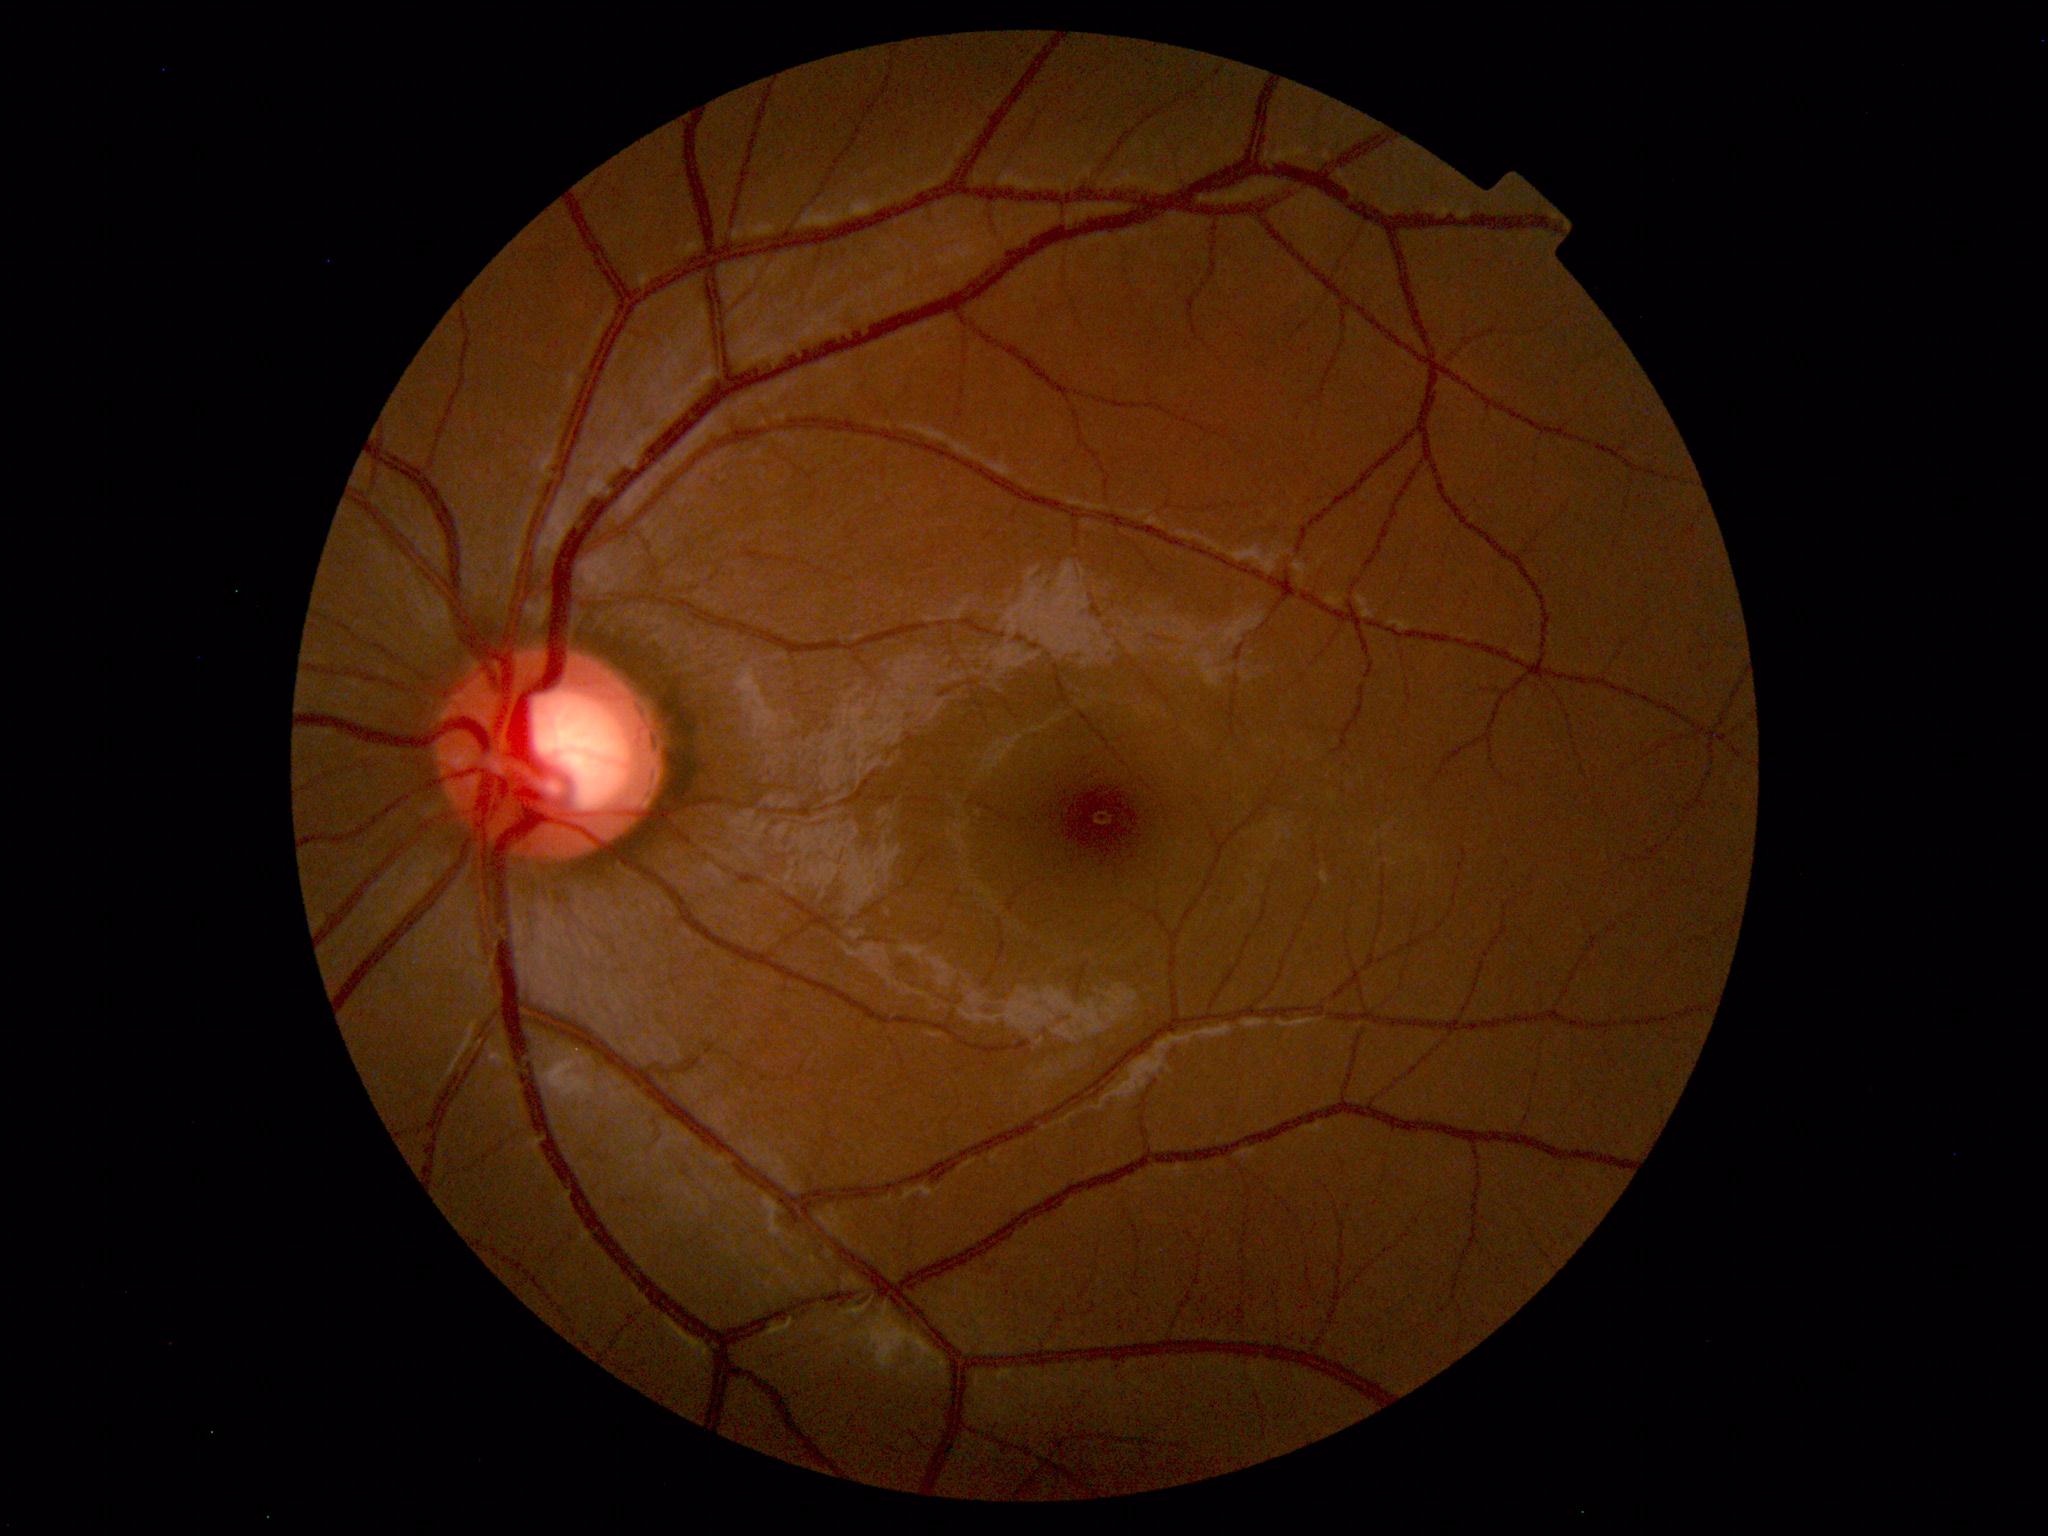

Diagnosis: normal.